DR severity per modified Davis staging
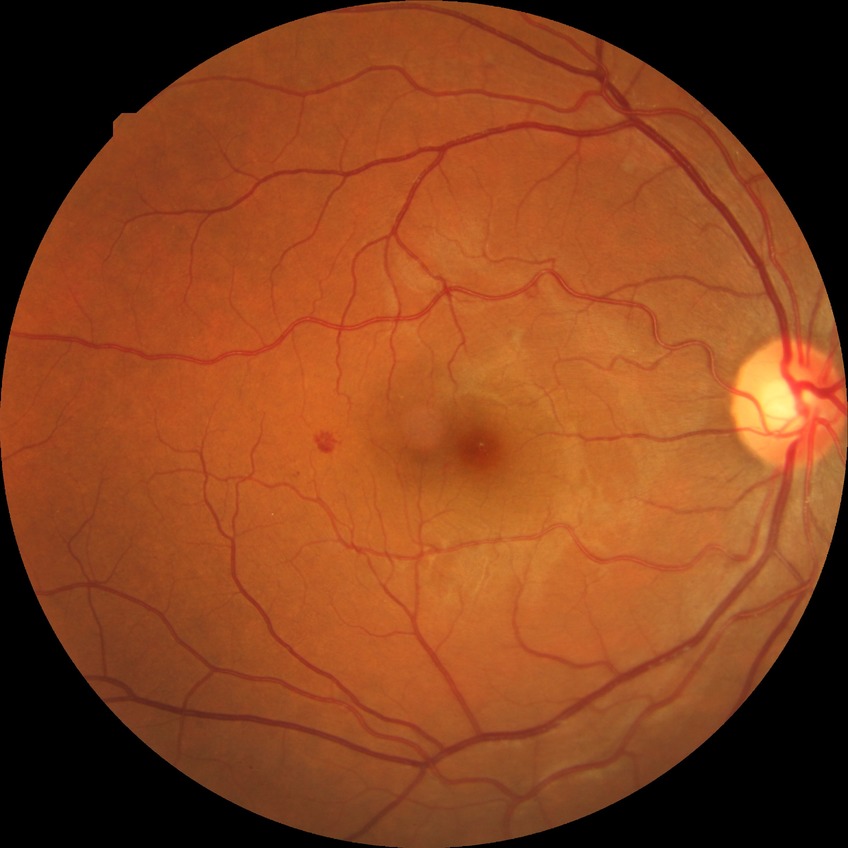 Diabetic retinopathy (DR): simple diabetic retinopathy (SDR).